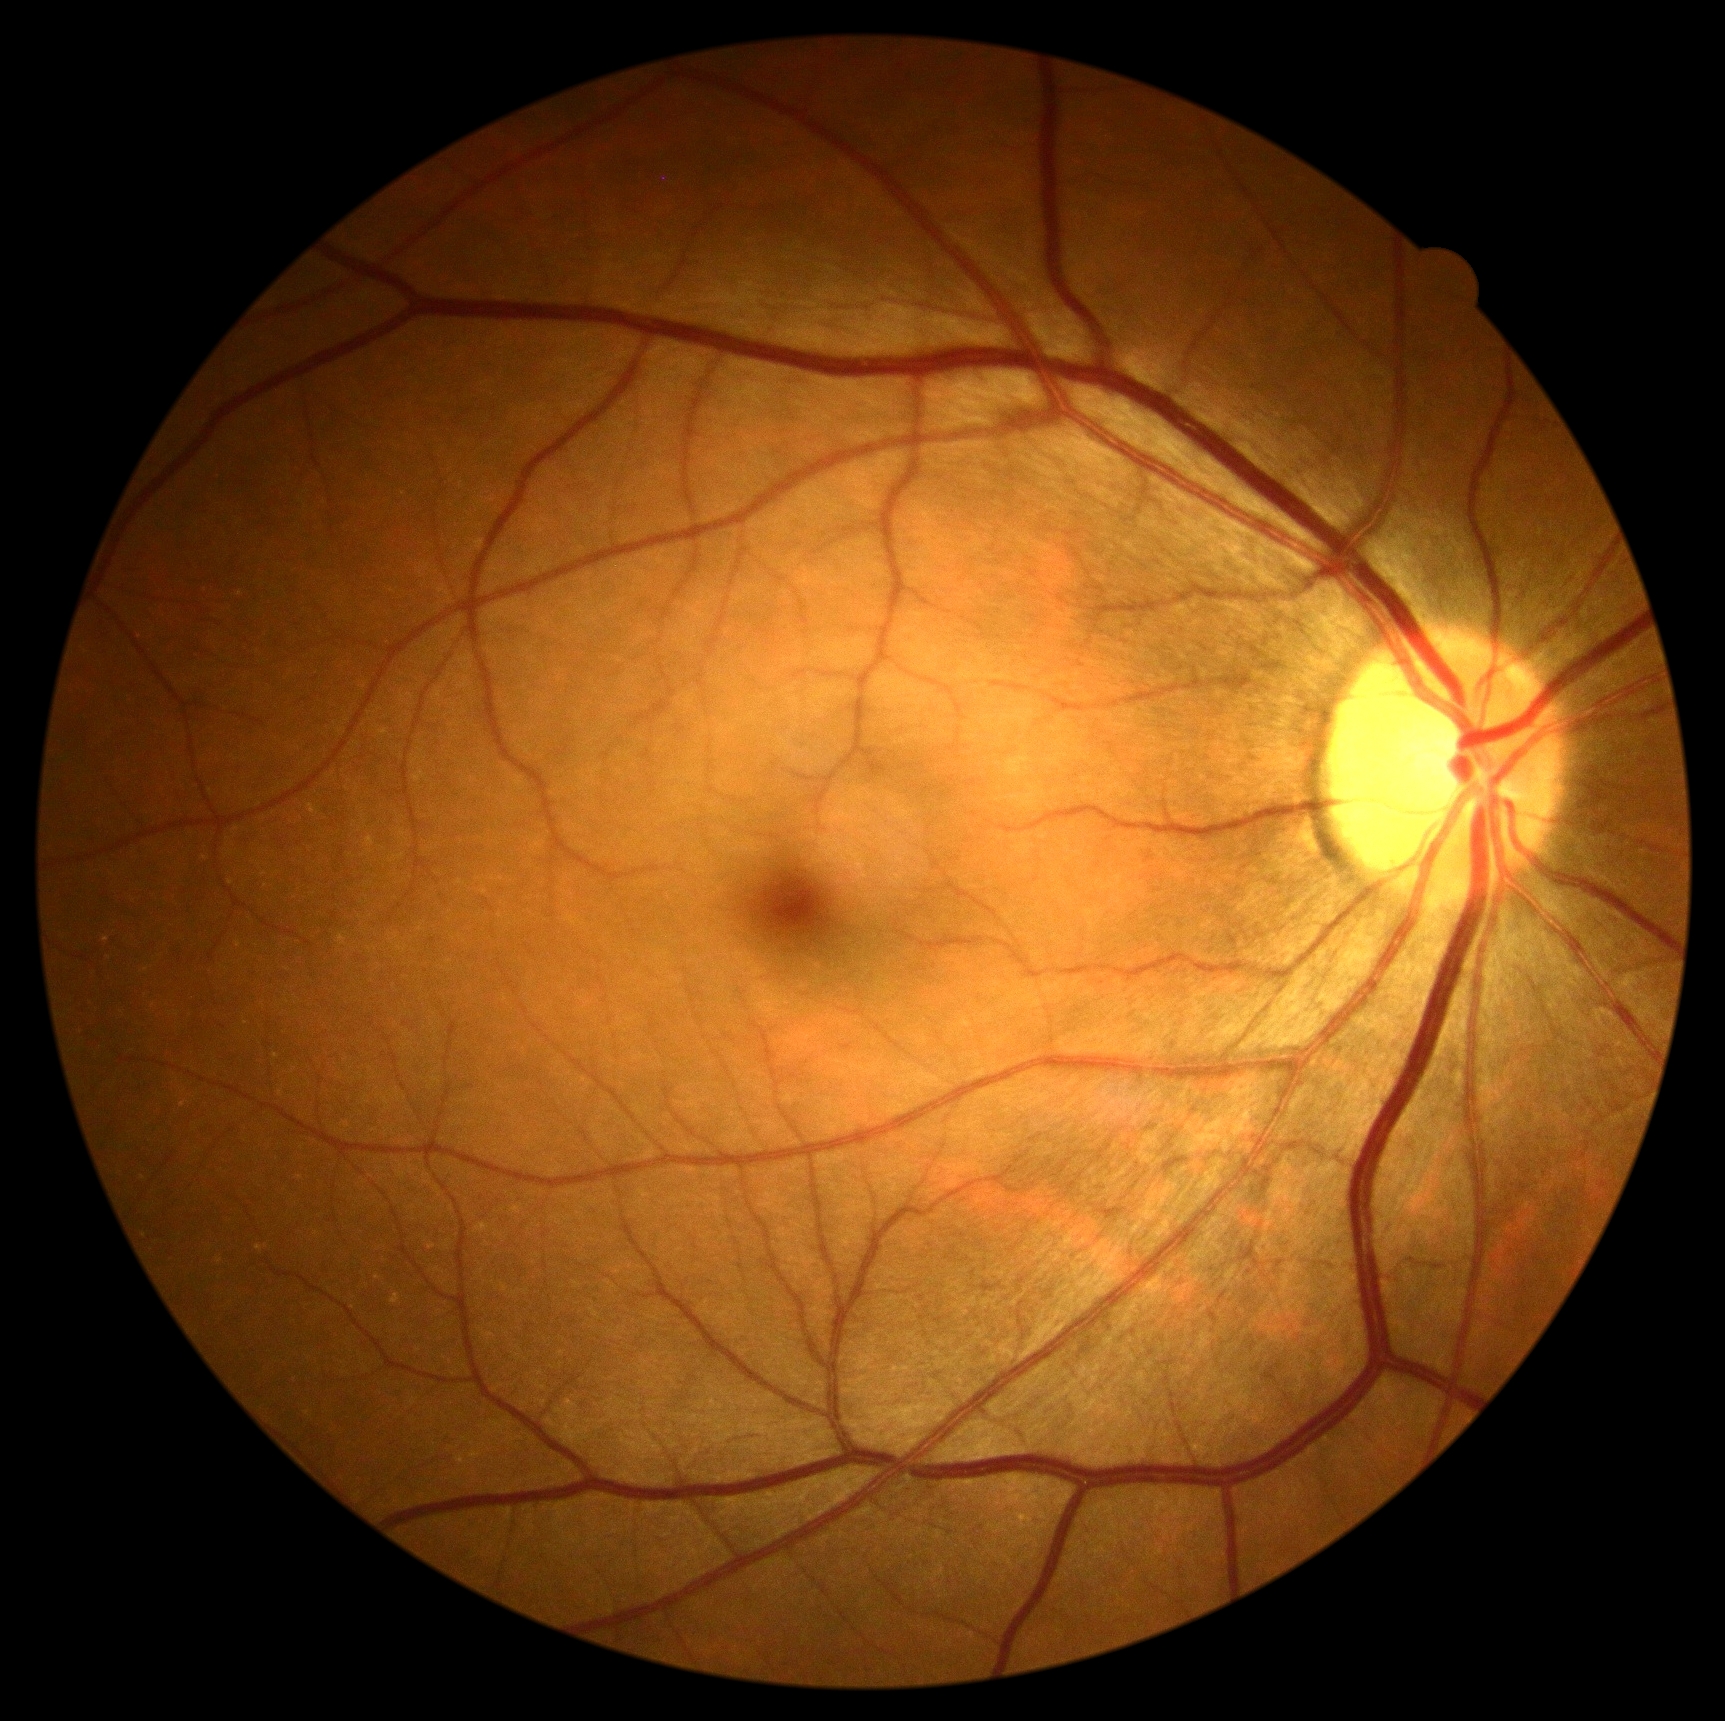 No apparent diabetic retinopathy.
DR: 0.